Posterior pole color fundus photograph. Without pupil dilation
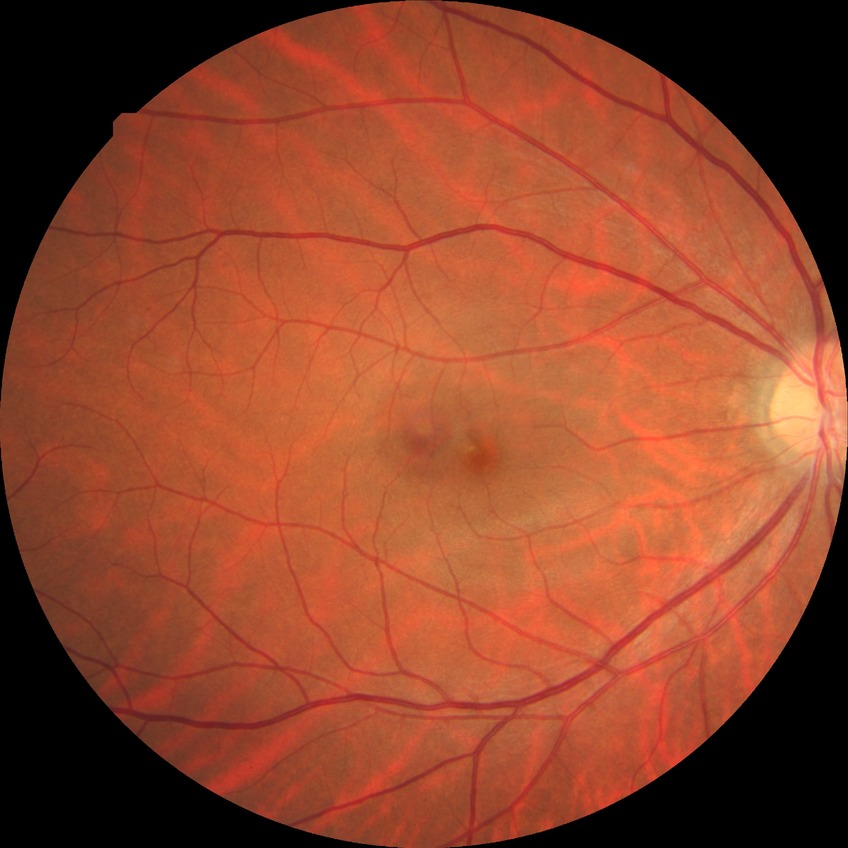 Diabetic retinopathy (DR): no diabetic retinopathy (NDR).